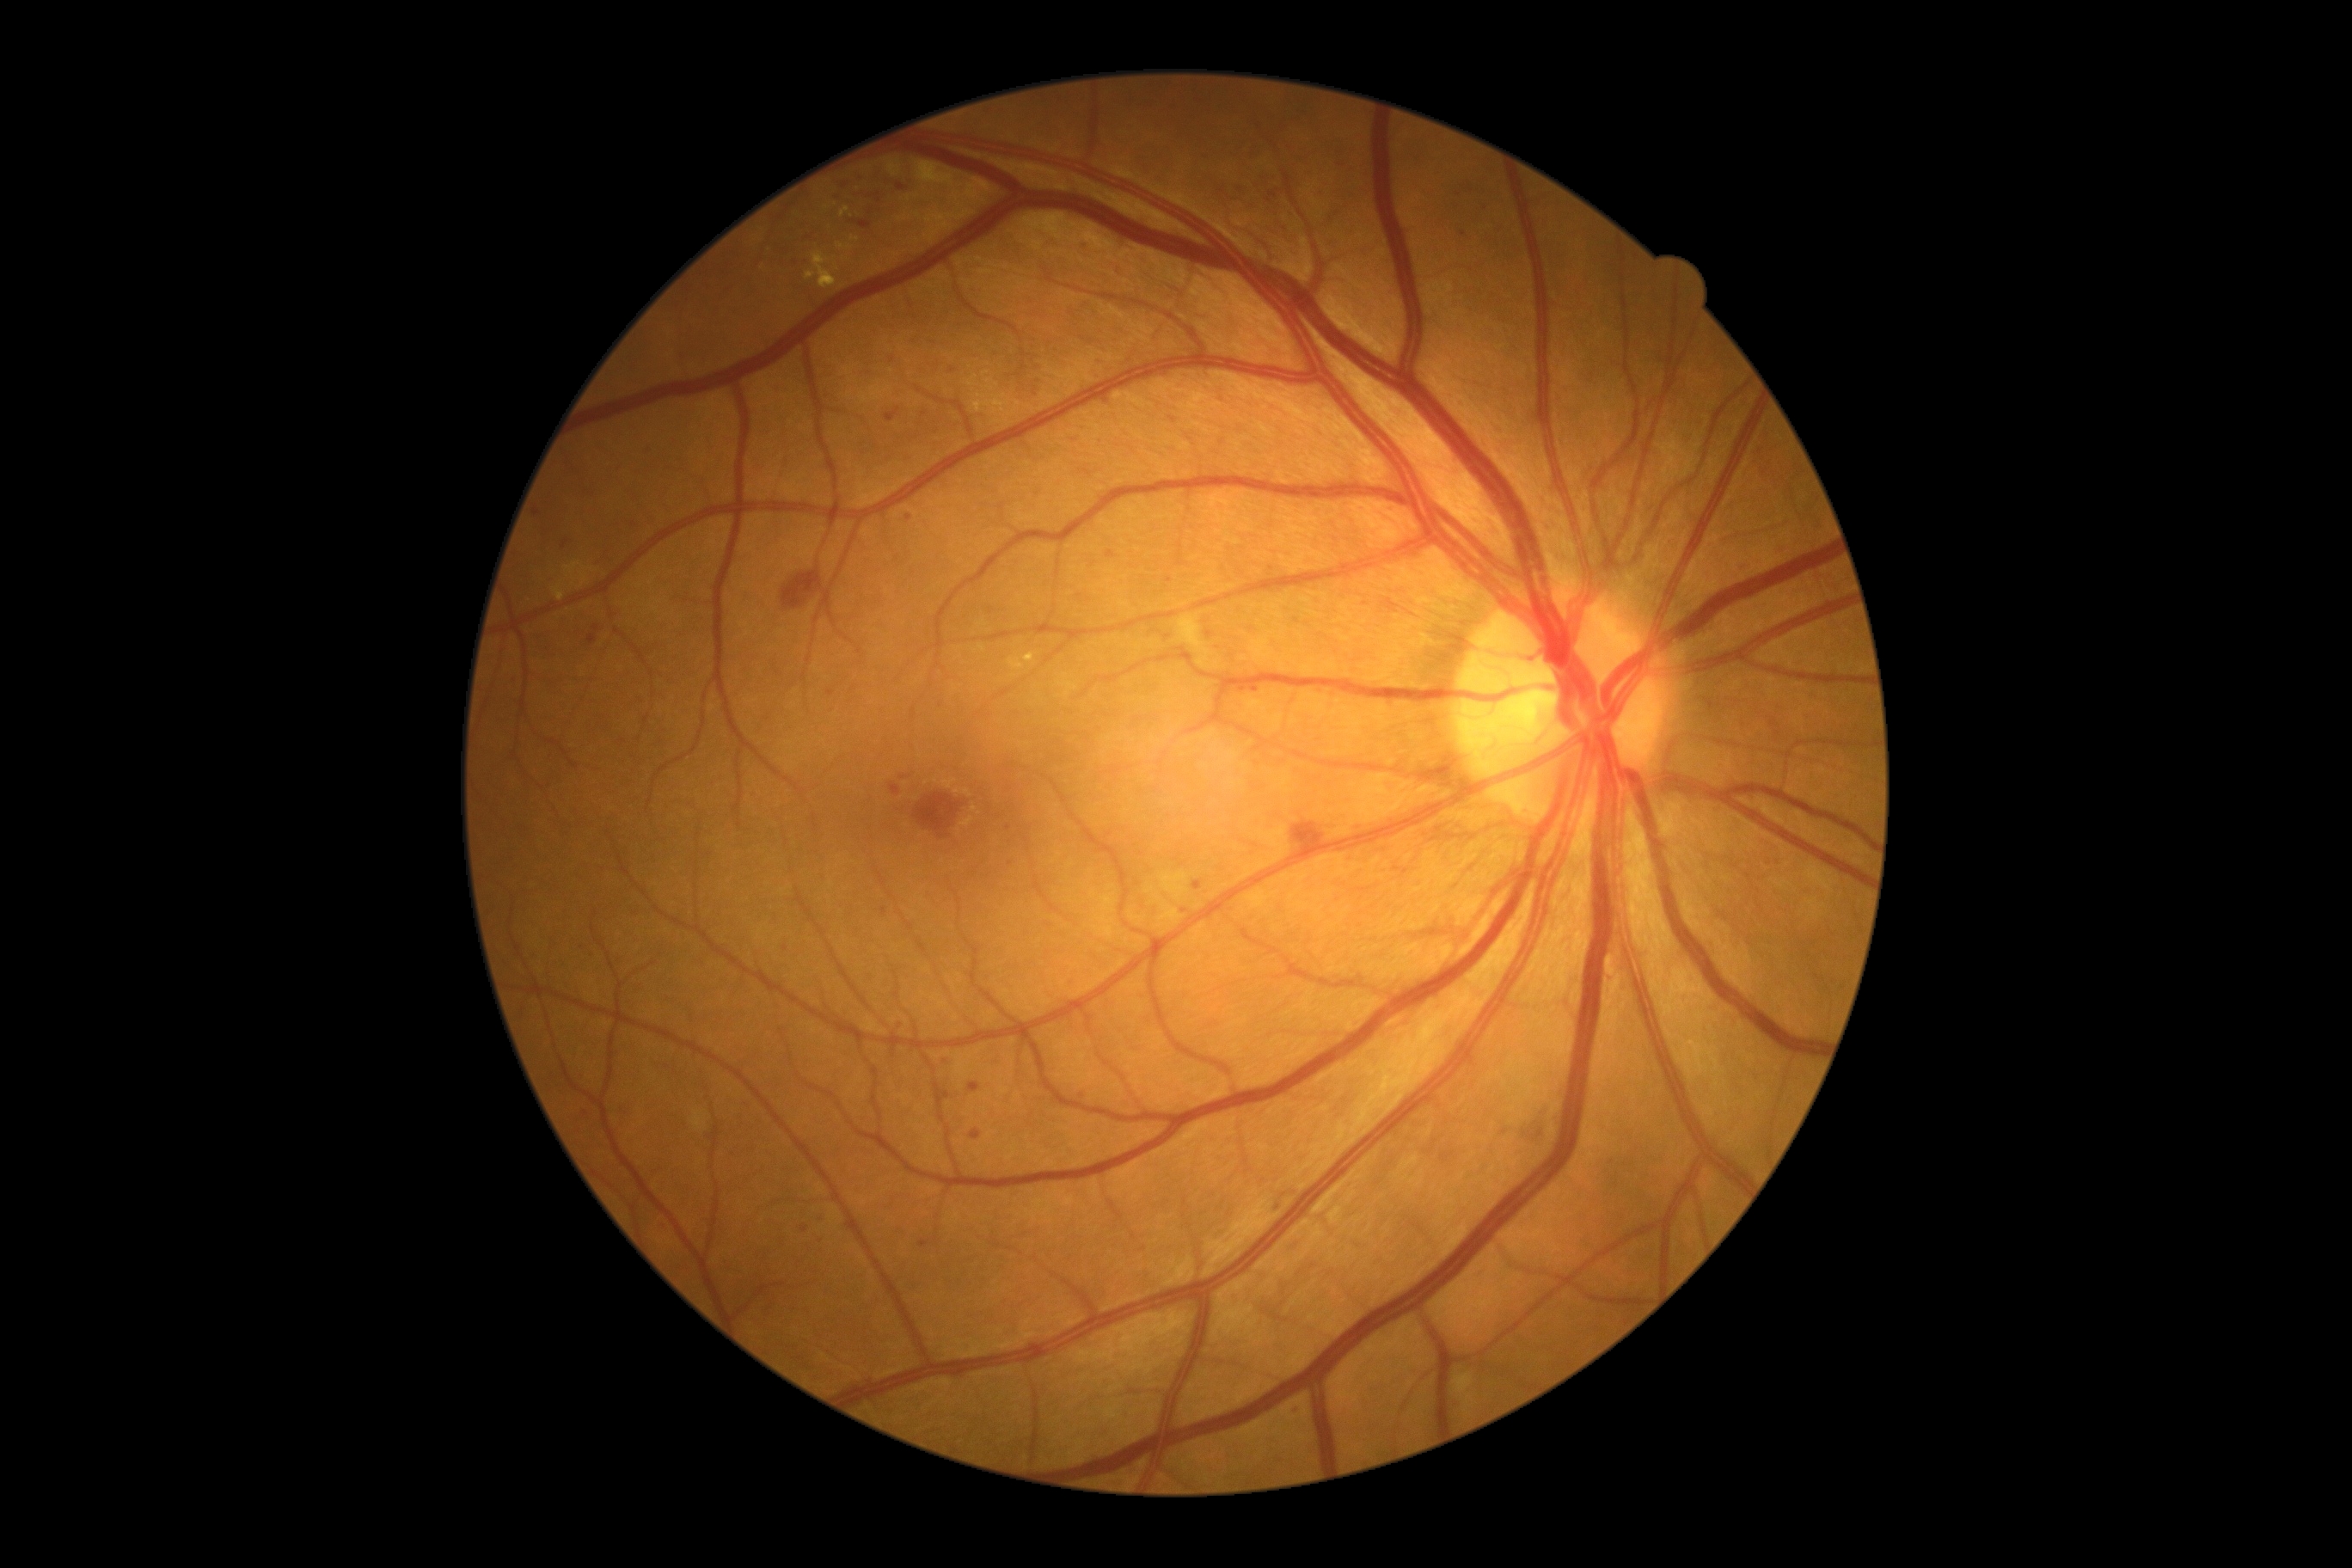

Diabetic retinopathy severity is moderate NPDR (grade 2)
Lesions identified (partial list):
hemorrhages: (783, 570, 824, 609) | (1292, 823, 1326, 848)
soft exudates: (692, 1112, 706, 1130) | (1454, 1373, 1476, 1416) | (1179, 615, 1210, 670)
microaneurysms (partial): (936, 654, 941, 666) | (1270, 1208, 1280, 1213) | (1292, 1409, 1302, 1419) | (1194, 881, 1203, 891) | (1270, 193, 1278, 199) | (1239, 687, 1247, 694) | (969, 1129, 983, 1141) | (919, 1240, 929, 1247) | (644, 450, 652, 460) | (587, 625, 601, 646)
Microaneurysms (small, approximate centers) near 909, 518 | 1464, 233 | 1082, 1096 | 786, 949 | 1027, 840 | 845, 185 | 804, 1228
hard exudates (partial): (805, 252, 836, 290) | (1008, 658, 1024, 671) | (842, 207, 850, 217) | (1024, 654, 1036, 663) | (553, 580, 565, 601)